Color fundus image, image size 2352x1568 — 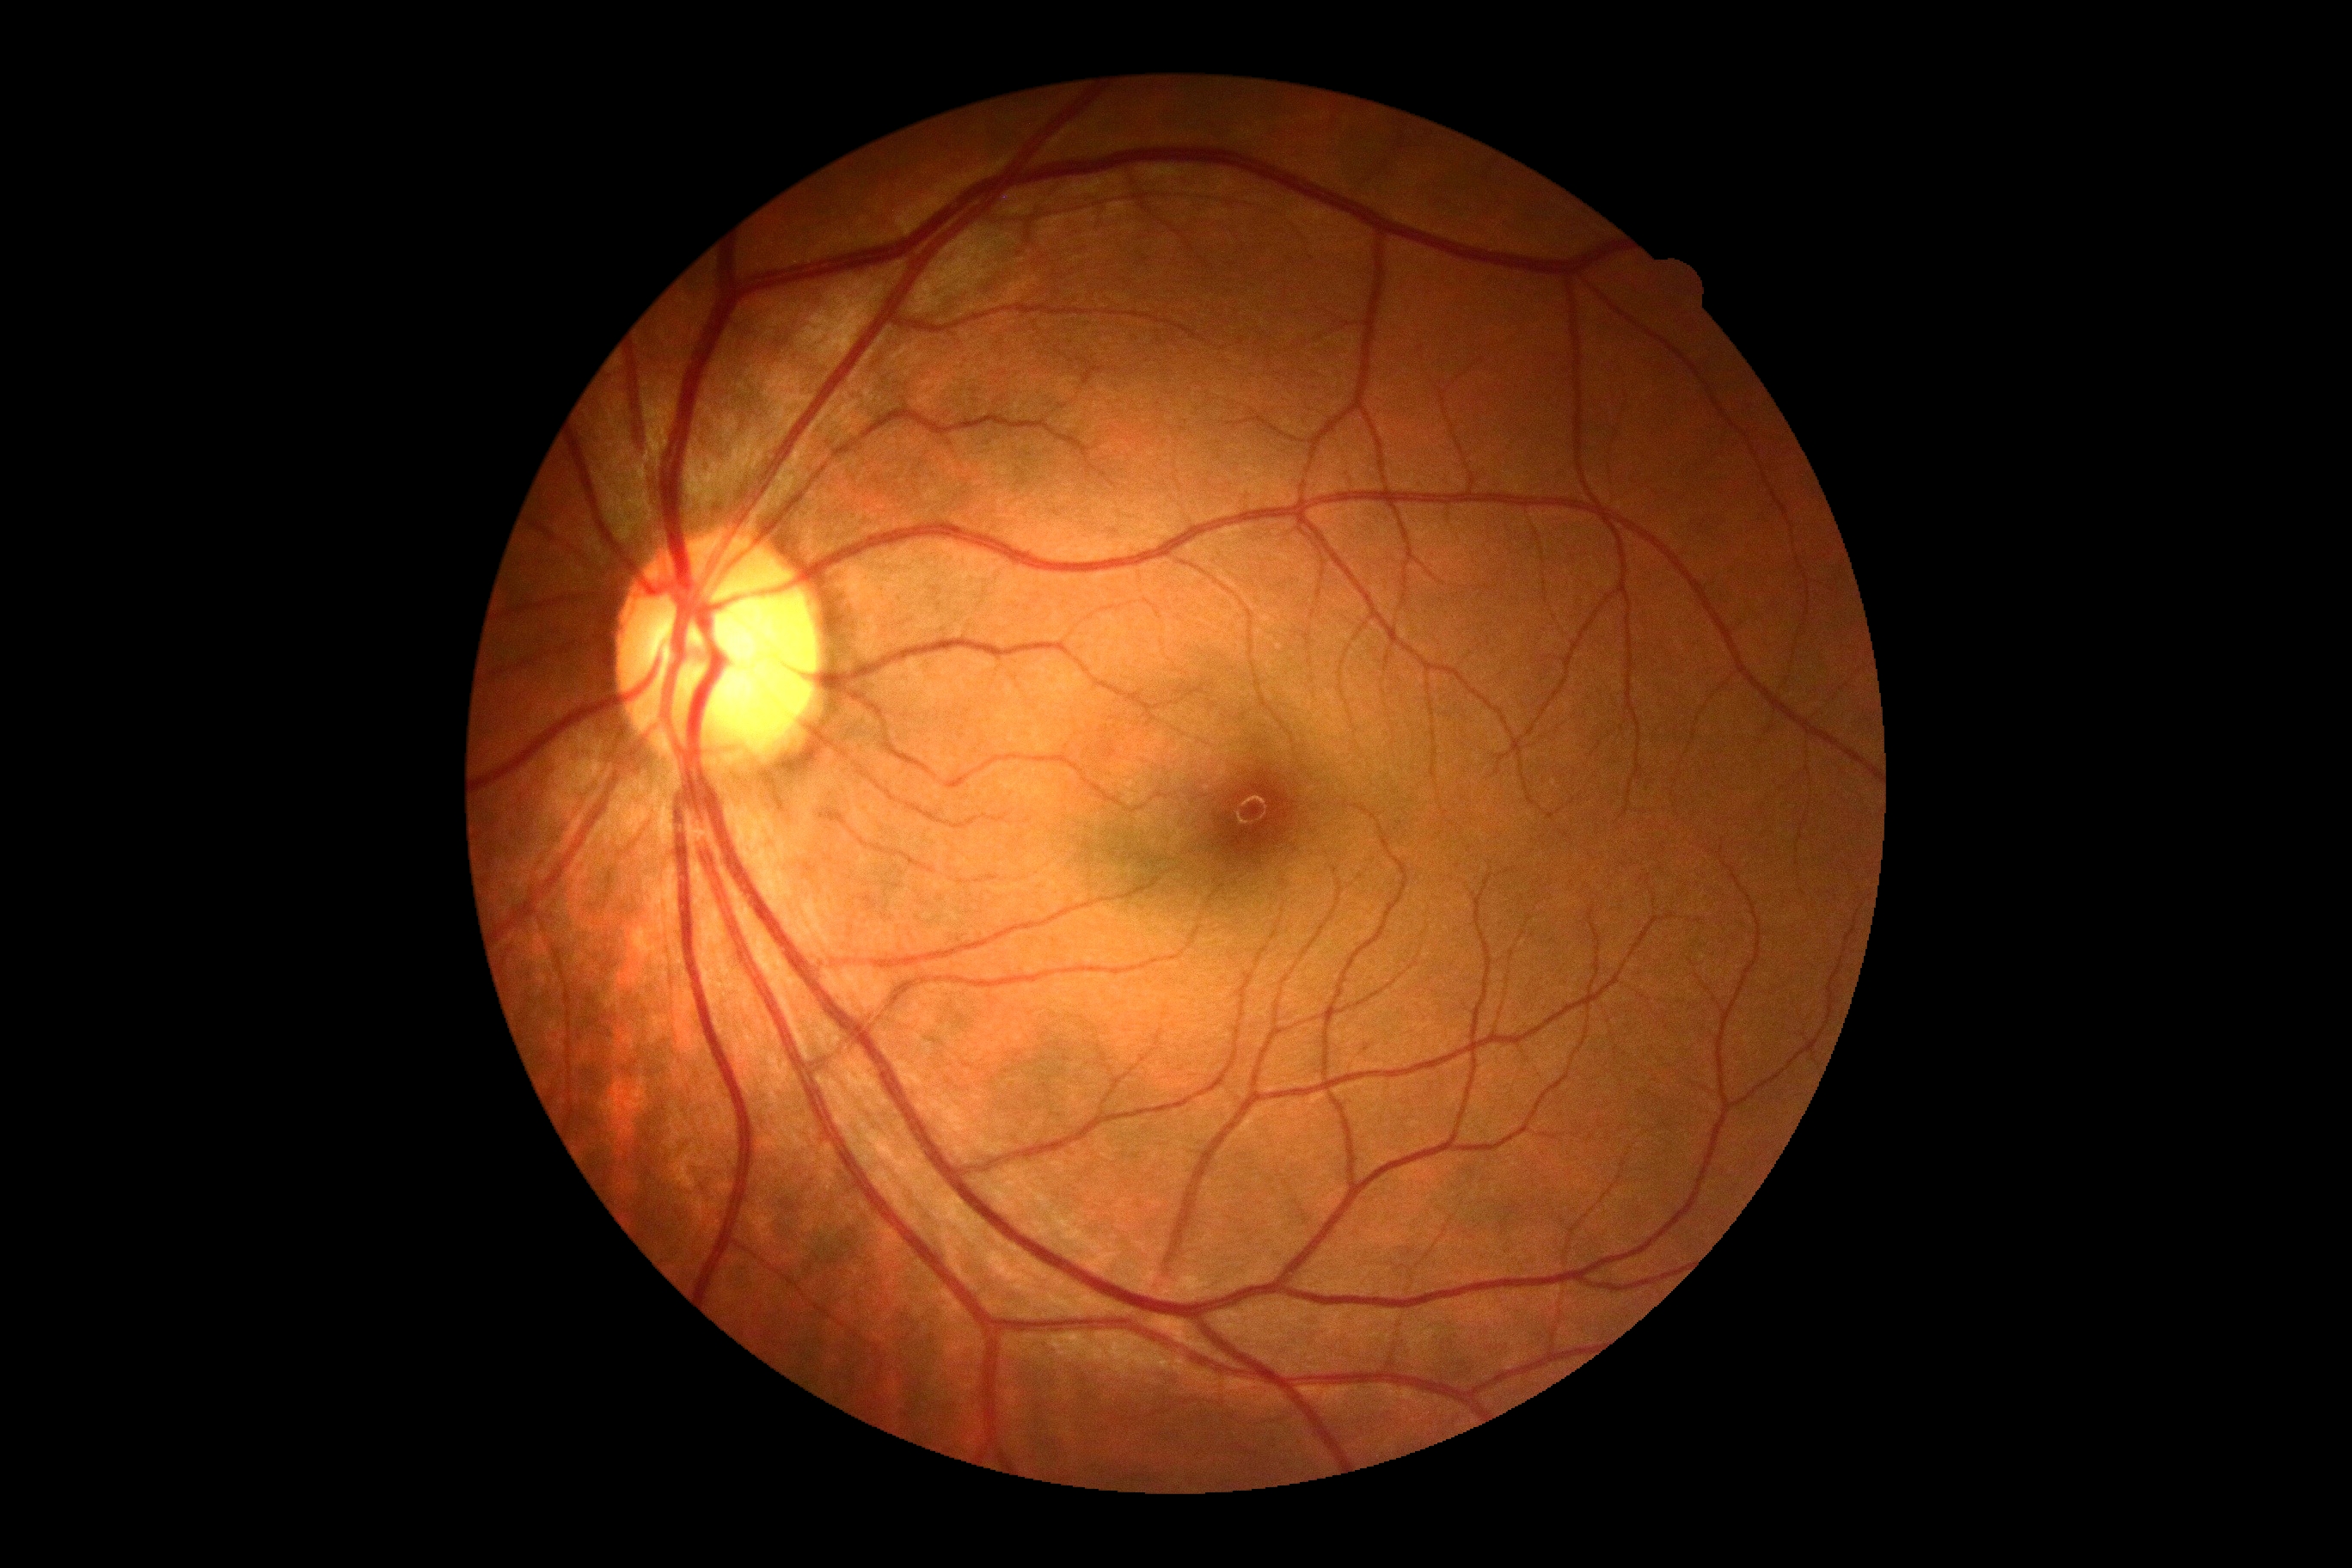 * DR impression: no signs of DR
* diabetic retinopathy (DR): grade 0 (no apparent retinopathy)